FOV: 45 degrees; CFP; 1932x1932px: 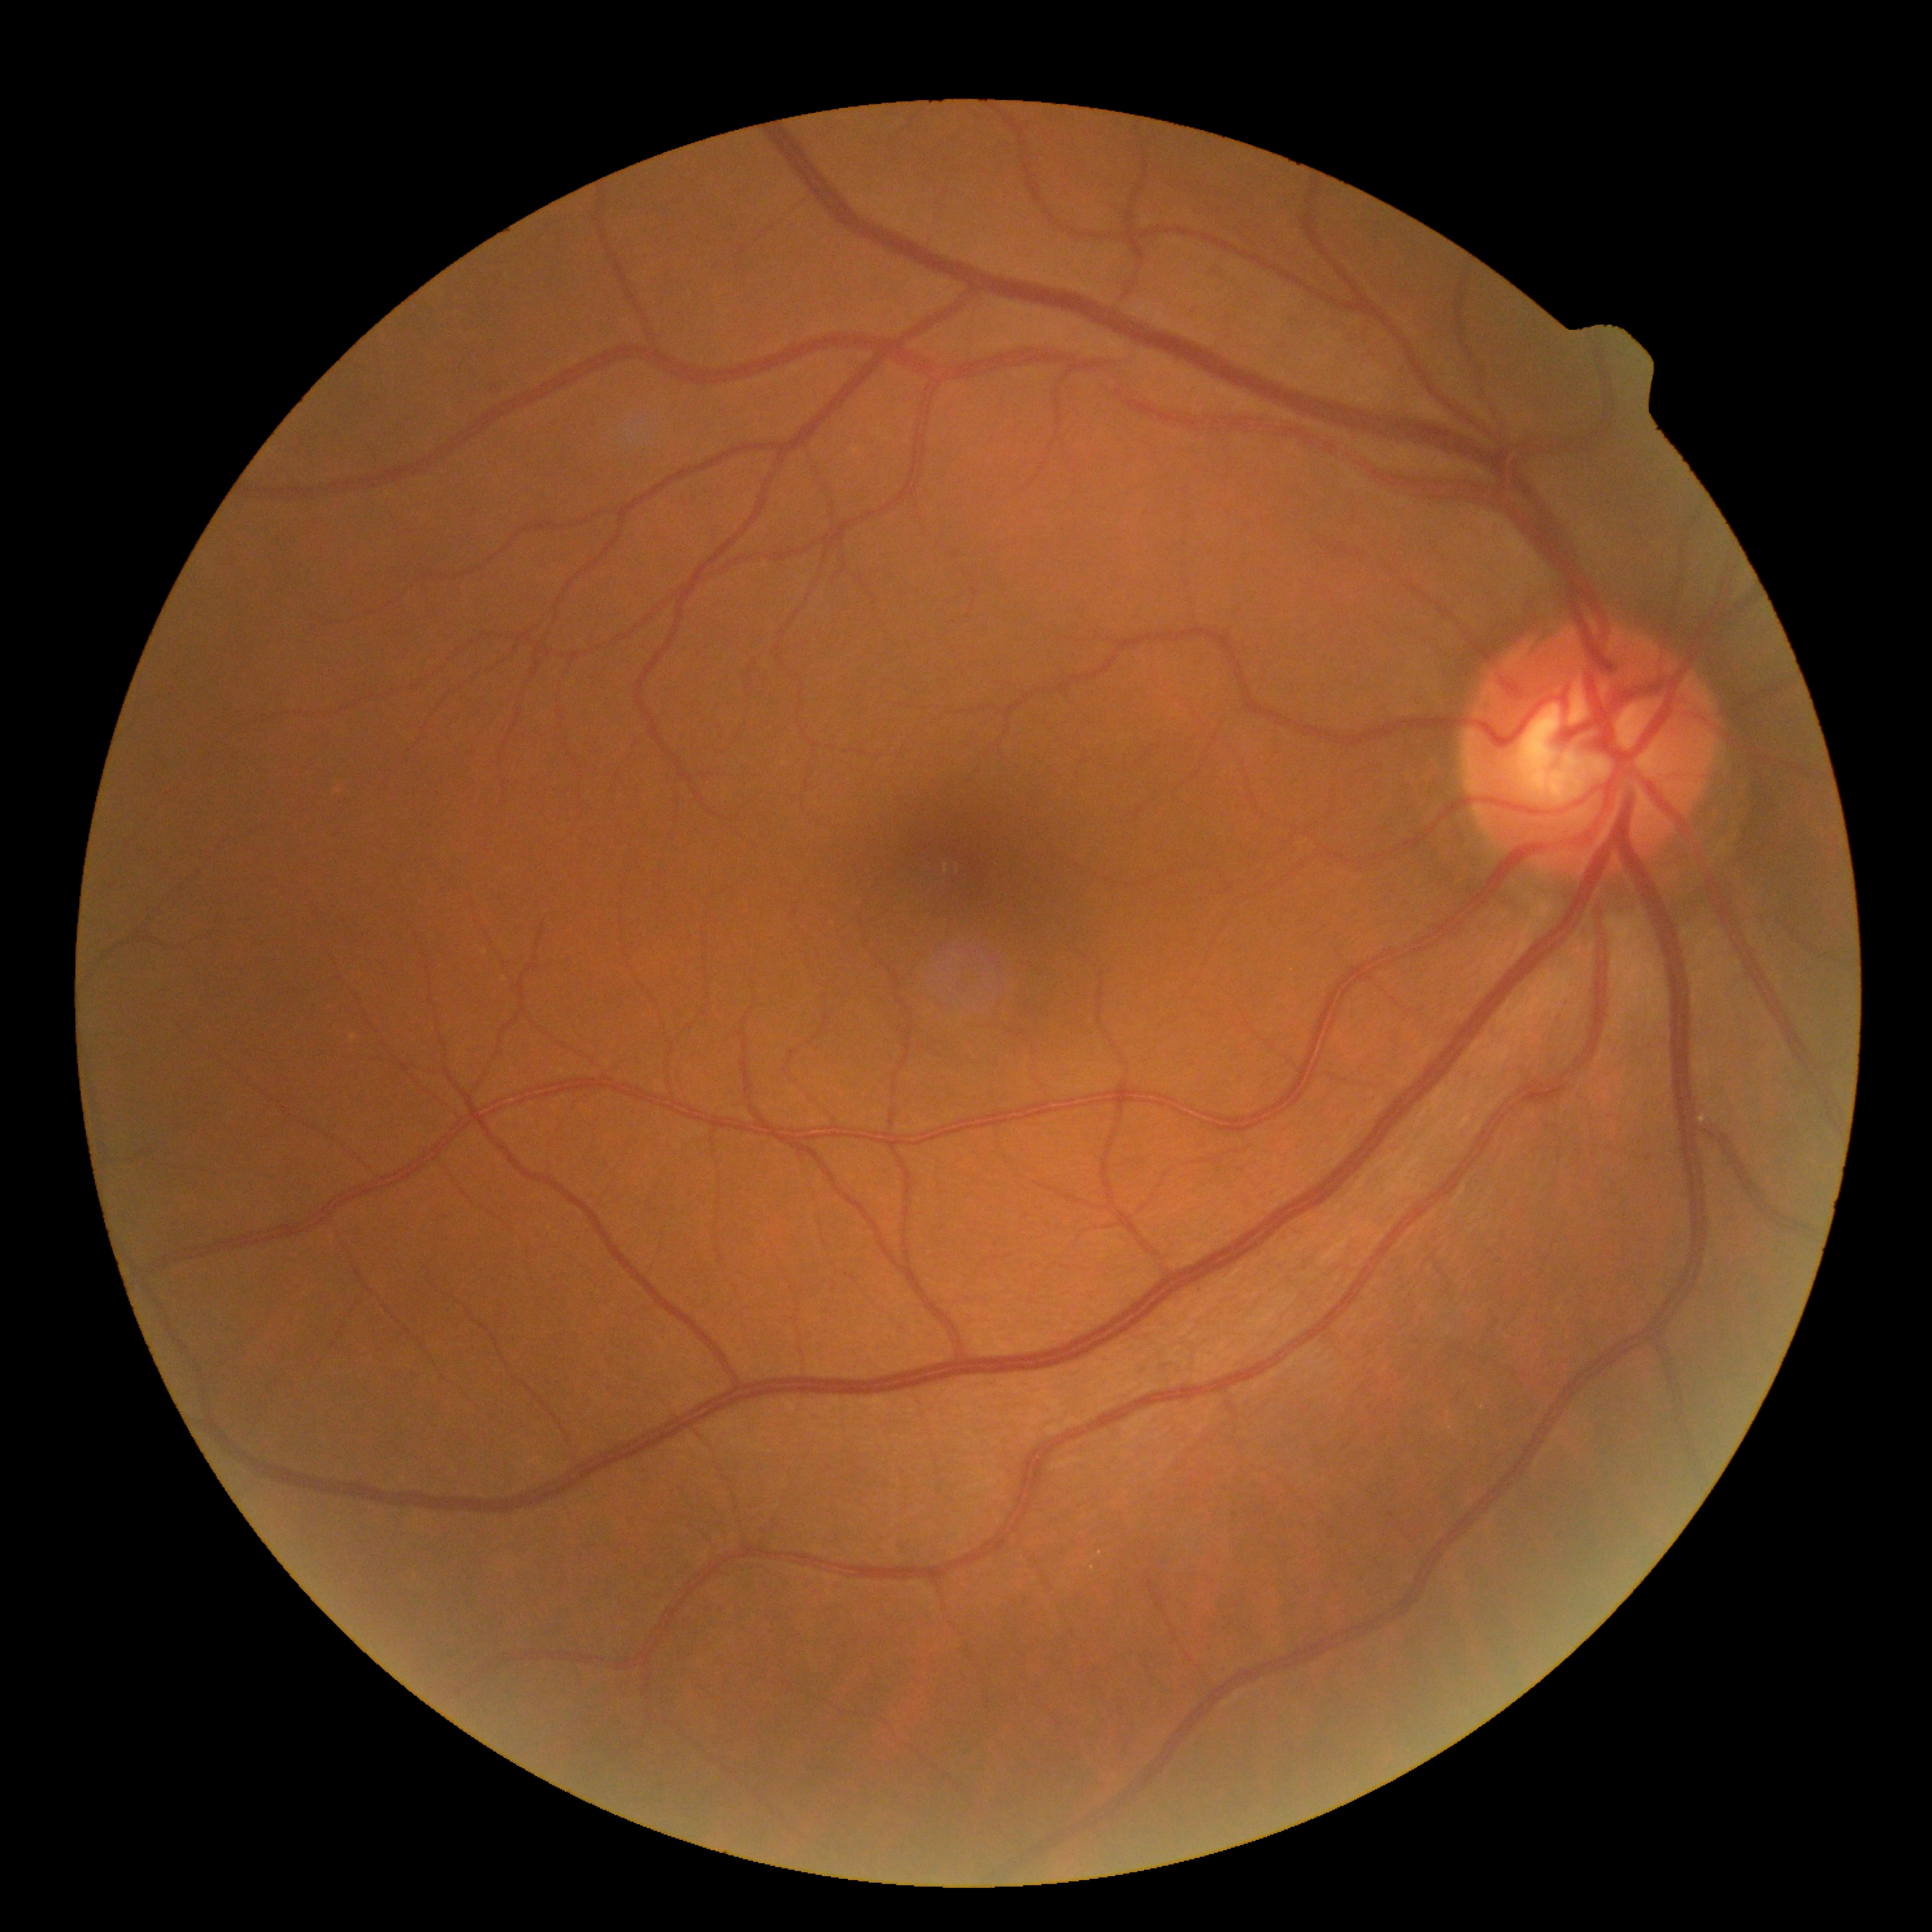

DR stage: grade 0 (no apparent retinopathy) | DR impression: no apparent DR.